Pediatric wide-field fundus photograph — 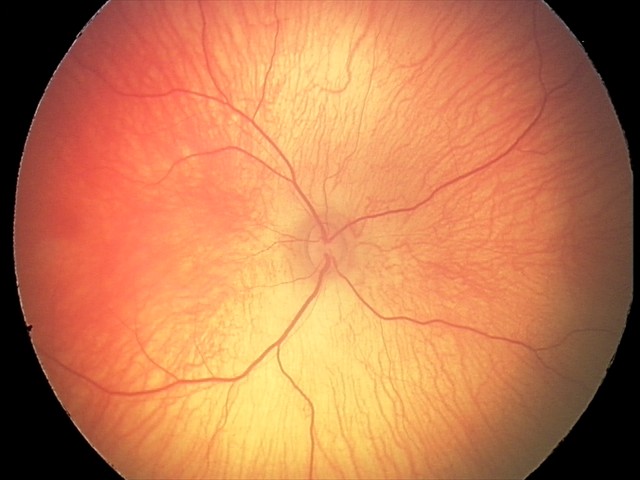 Screening examination diagnosed as physiological.